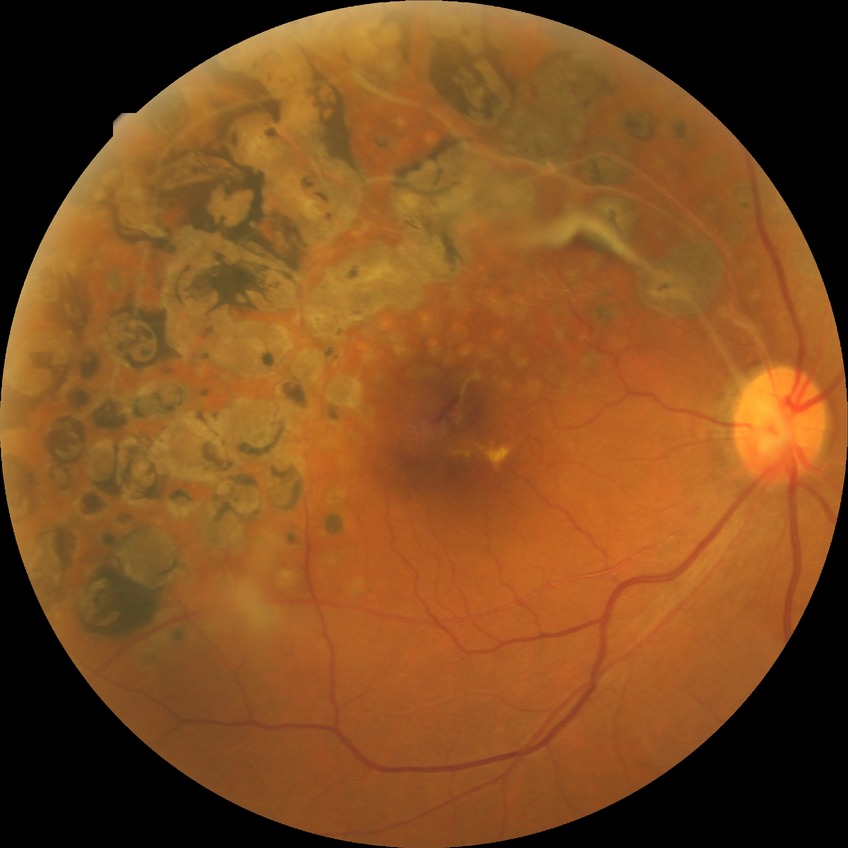

diabetic retinopathy (DR) = NDR (no diabetic retinopathy)